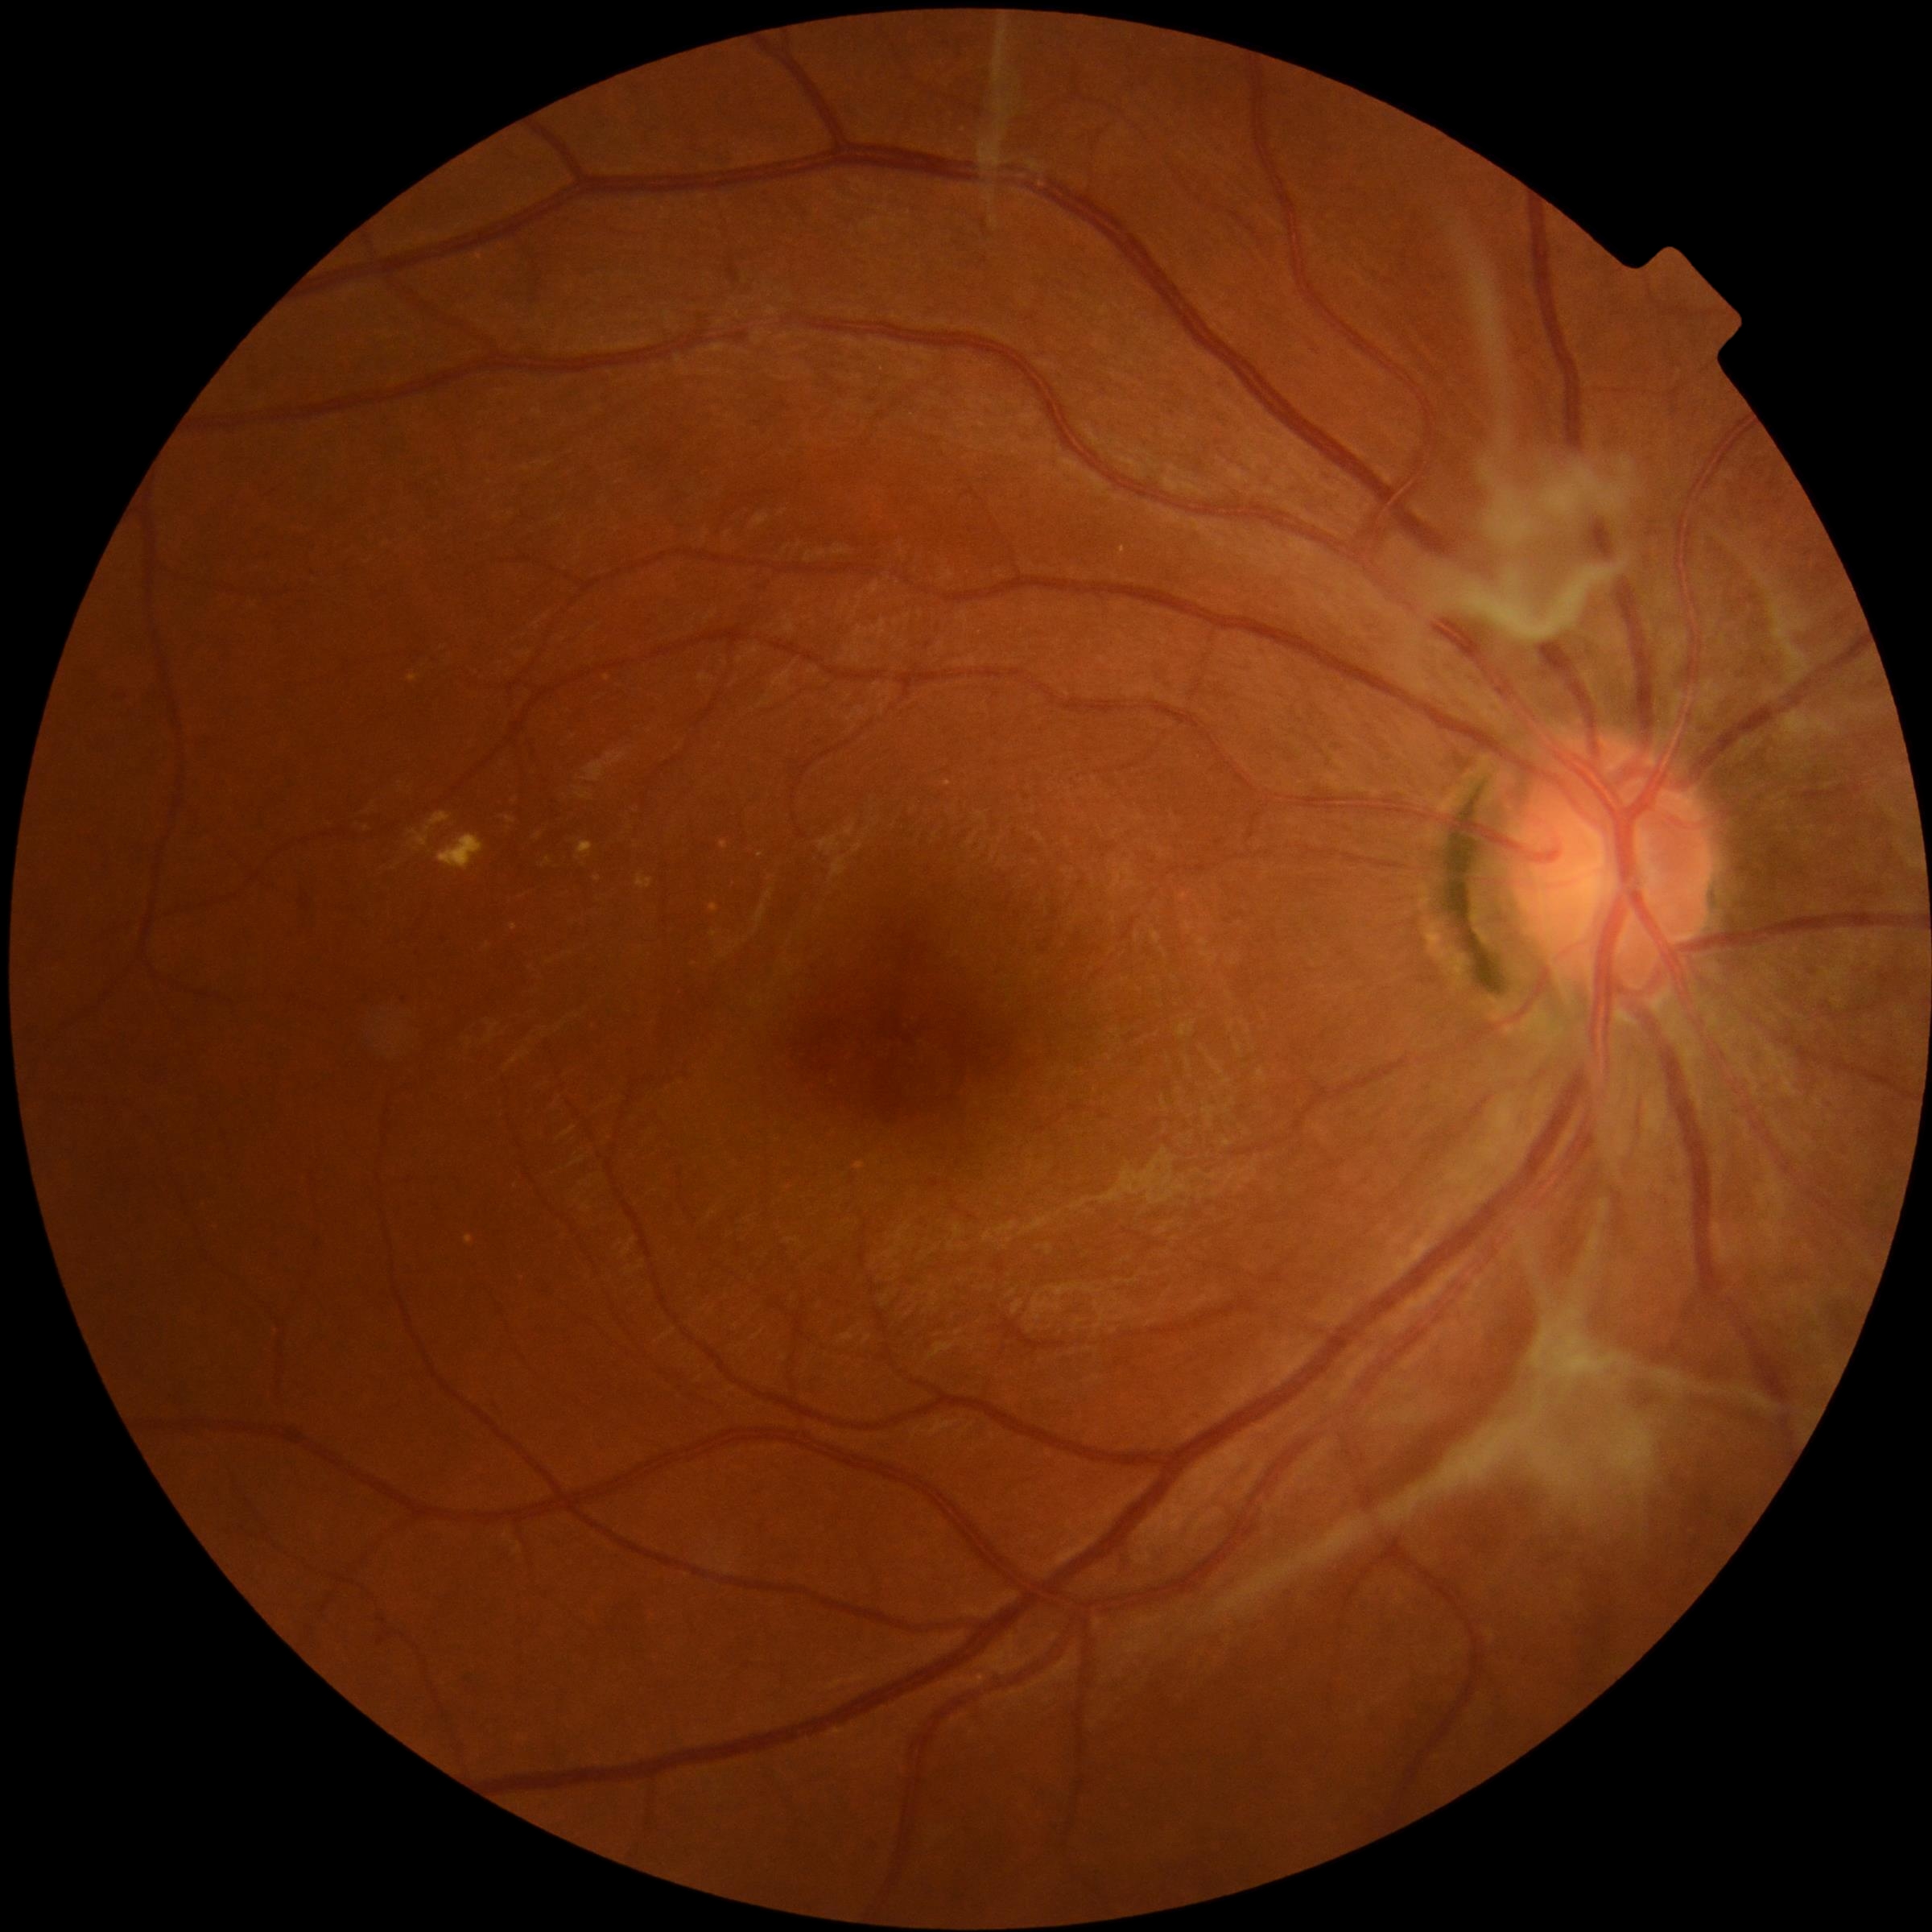 DR grade is 4 (PDR) — neovascularization and/or vitreous/pre-retinal hemorrhage
SEs: none
EXs: (411,812,452,853) | (546,857,553,865) | (408,675,419,683) | (439,834,485,872) | (535,832,542,840) | (638,873,654,889) | (506,817,515,824) | (577,842,594,861)
Small EXs near 599, 879
MAs: (378,1637,386,1645) | (397,996,407,1007) | (931,1179,939,1187)
Small MAs near 383, 1621 | 444, 938
HEs: none